100° field of view (Phoenix ICON) · wide-field fundus image from infant ROP screening — 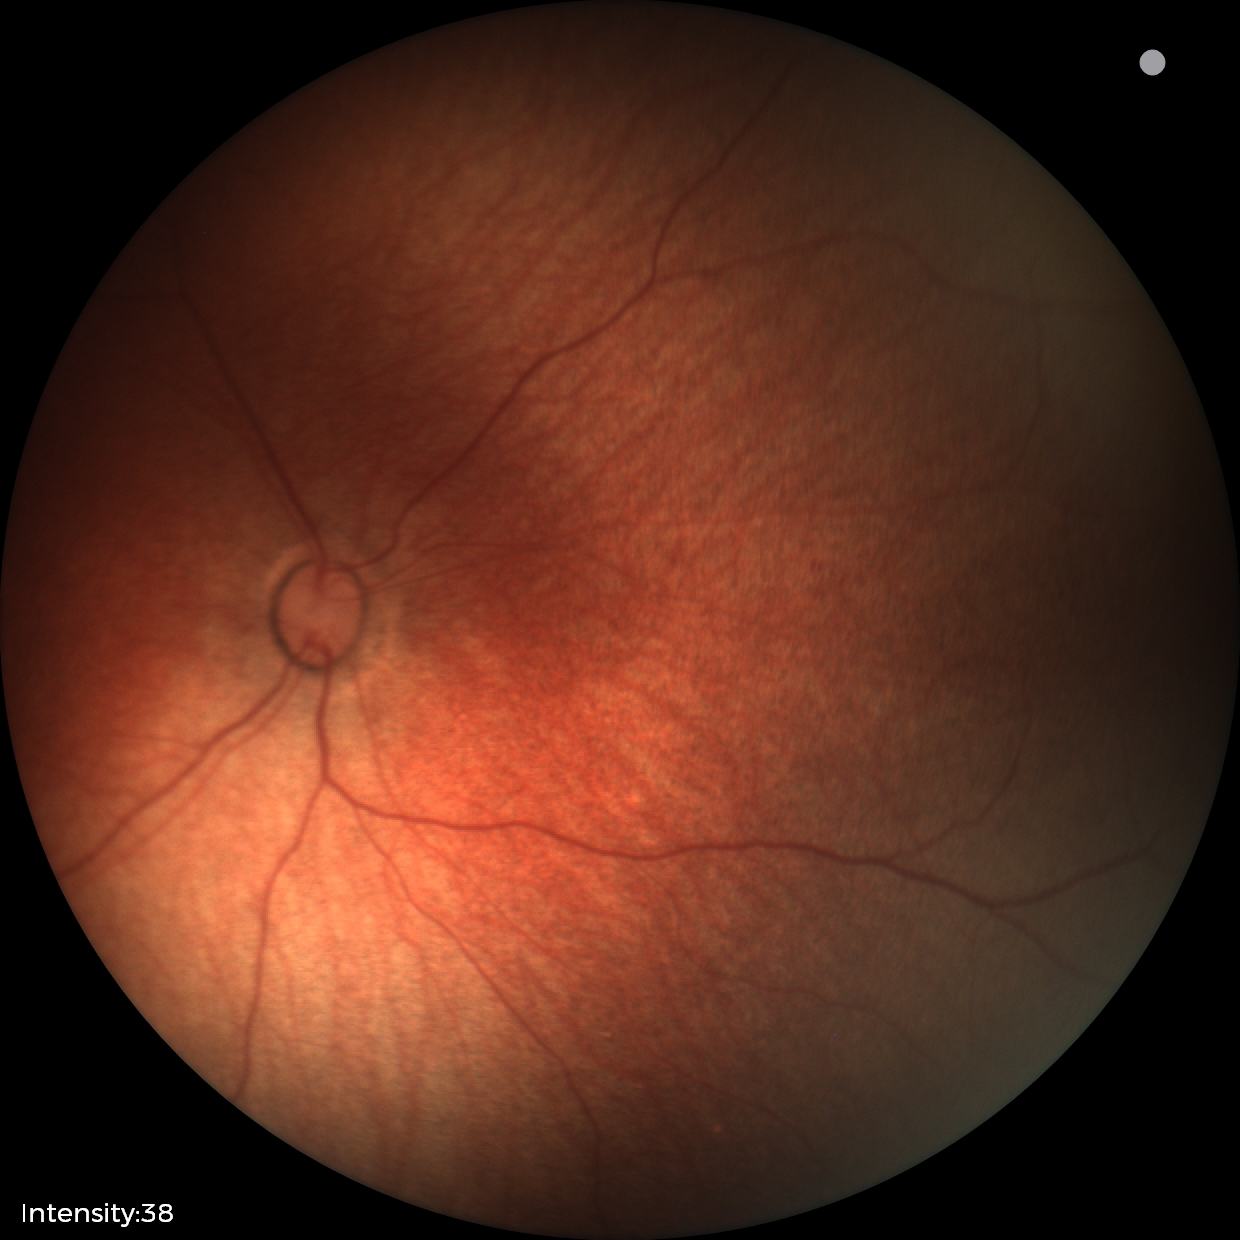 Screening diagnosis = normal retinal appearance.